45 degree fundus photograph, NIDEK AFC-230, image size 848x848: 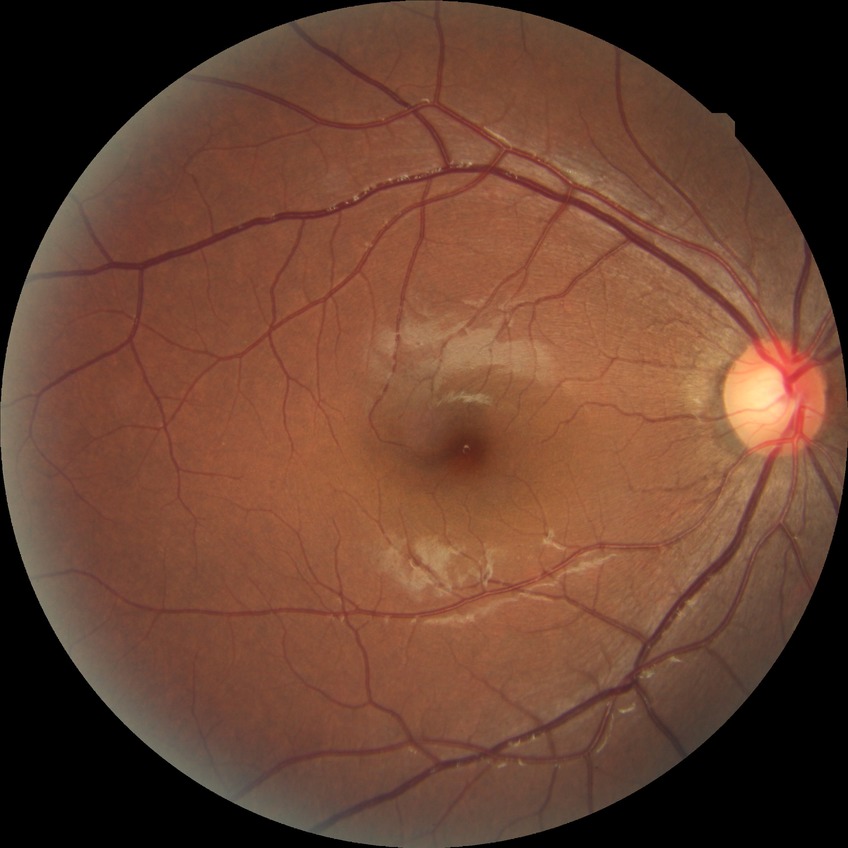

Assessment:
* Davis DR grade — NDR